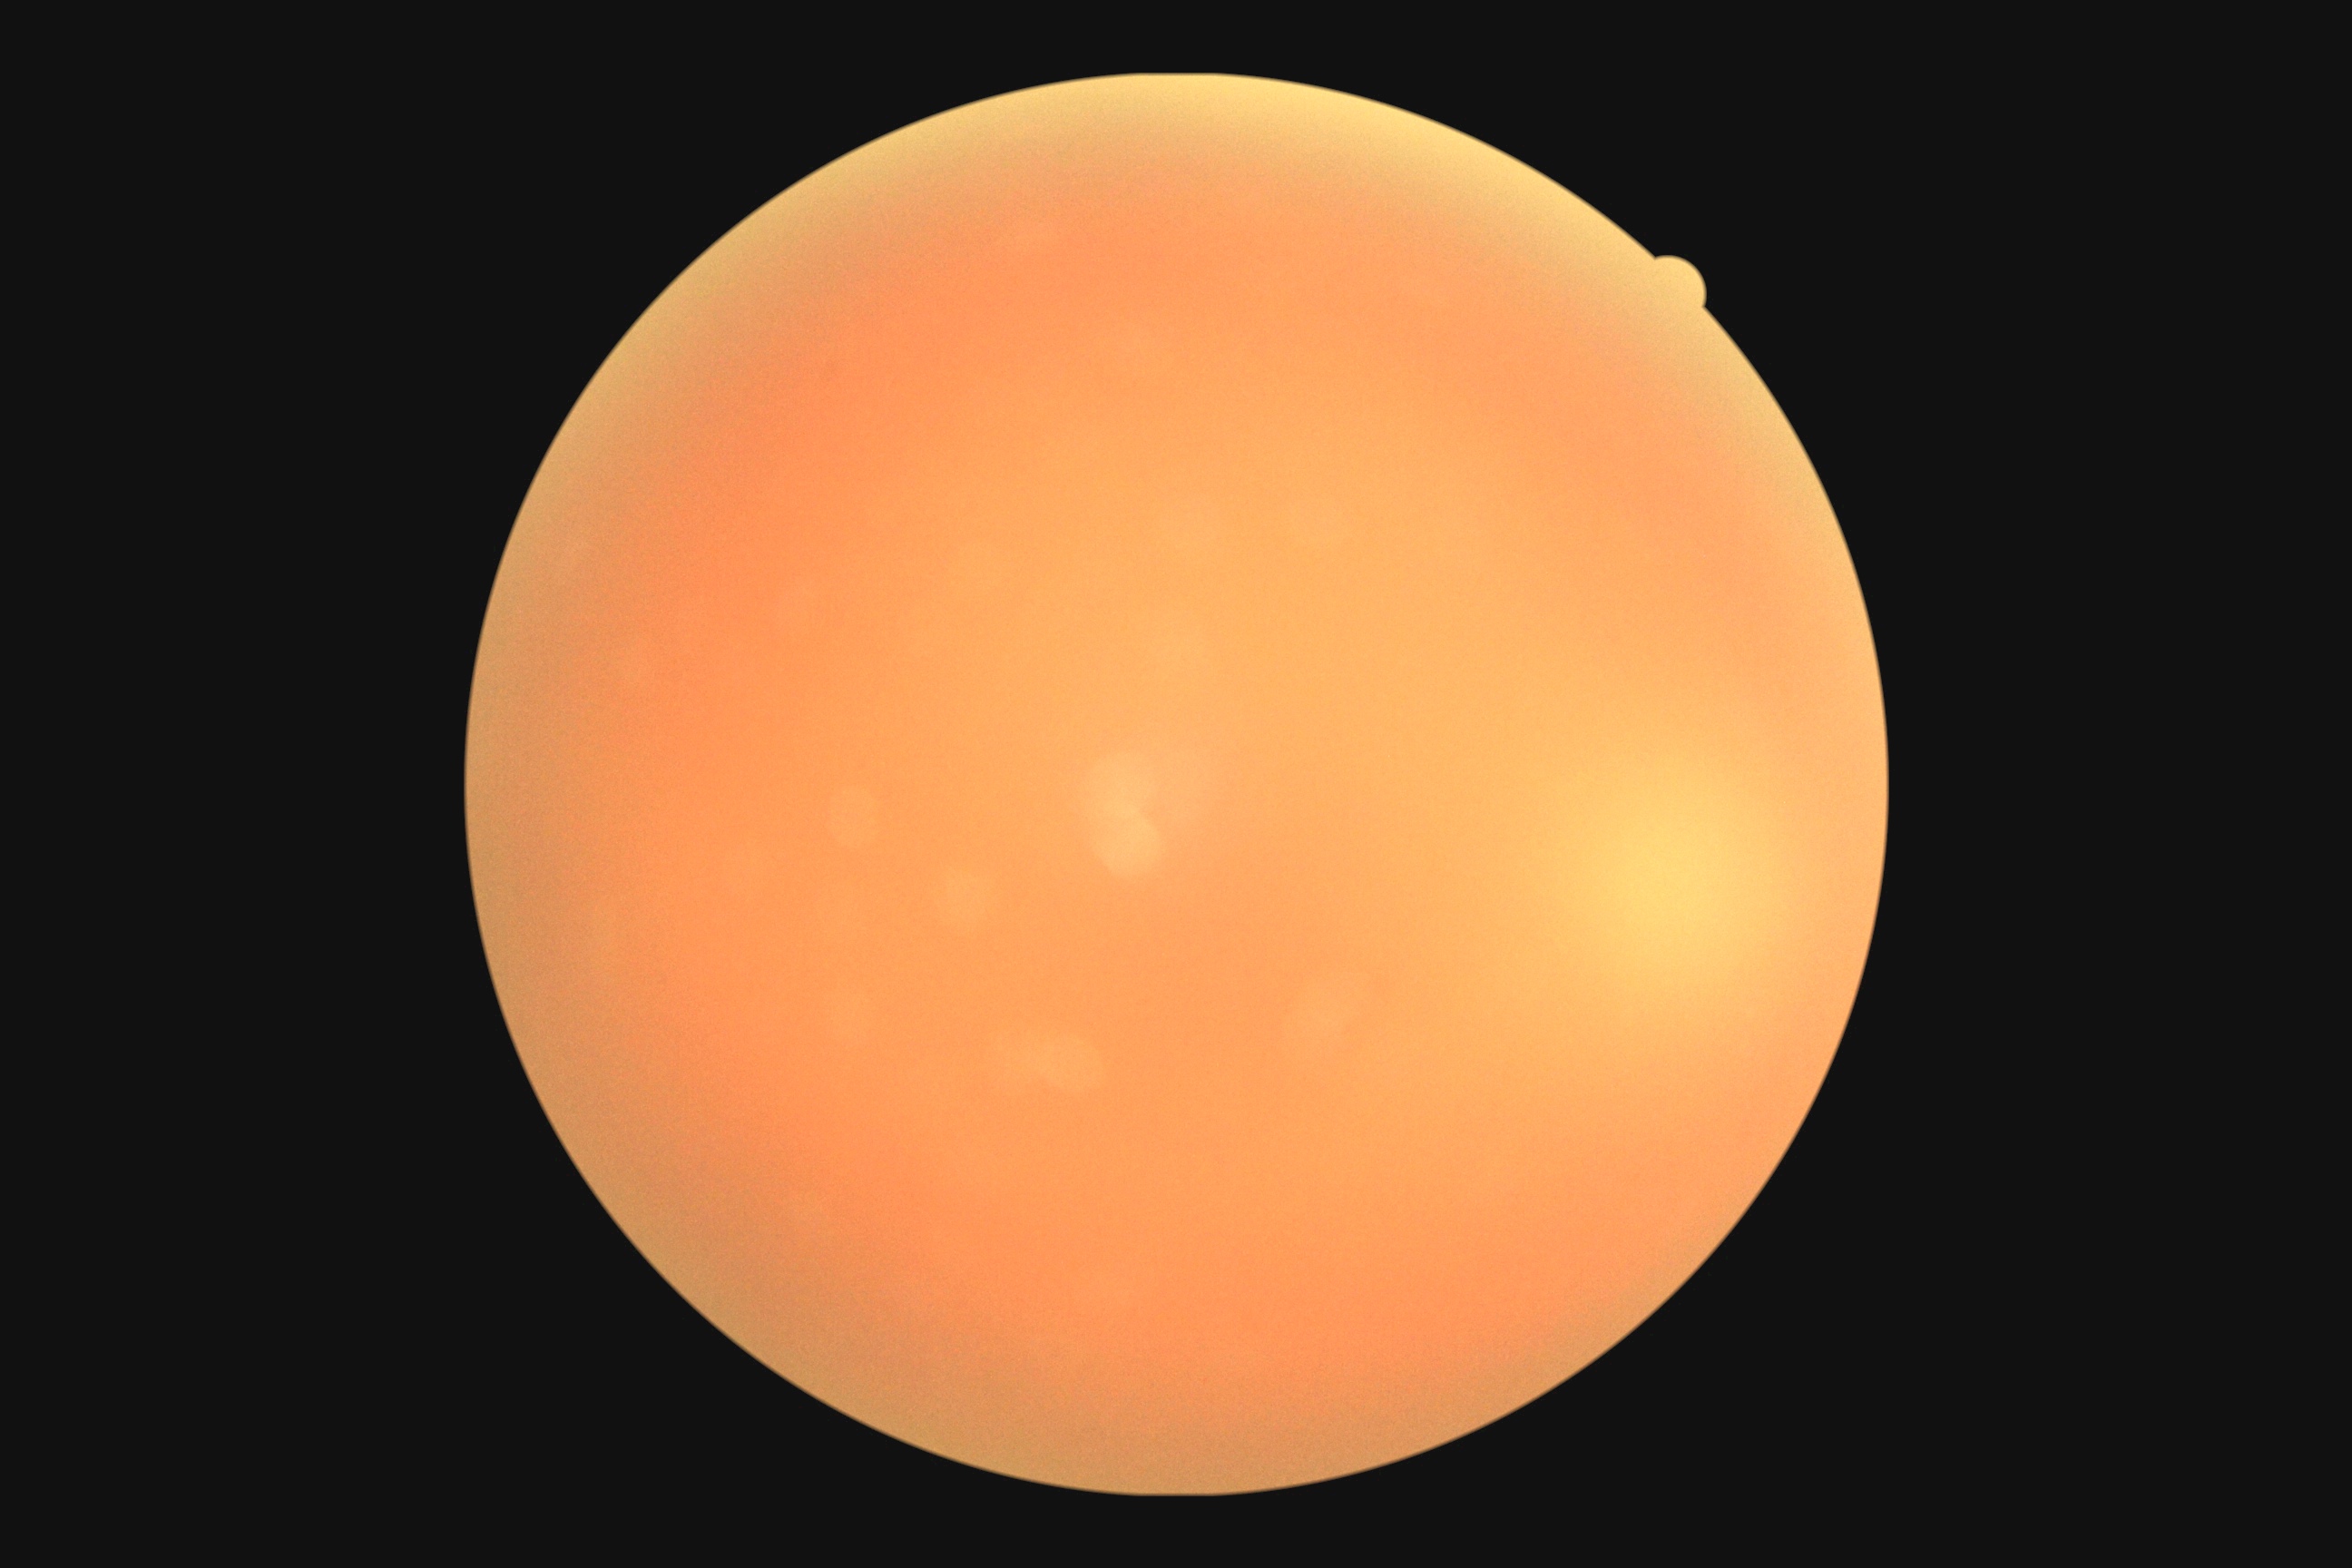
Diabetic retinopathy severity: ungradable due to poor image quality.